Modified Davis grading — 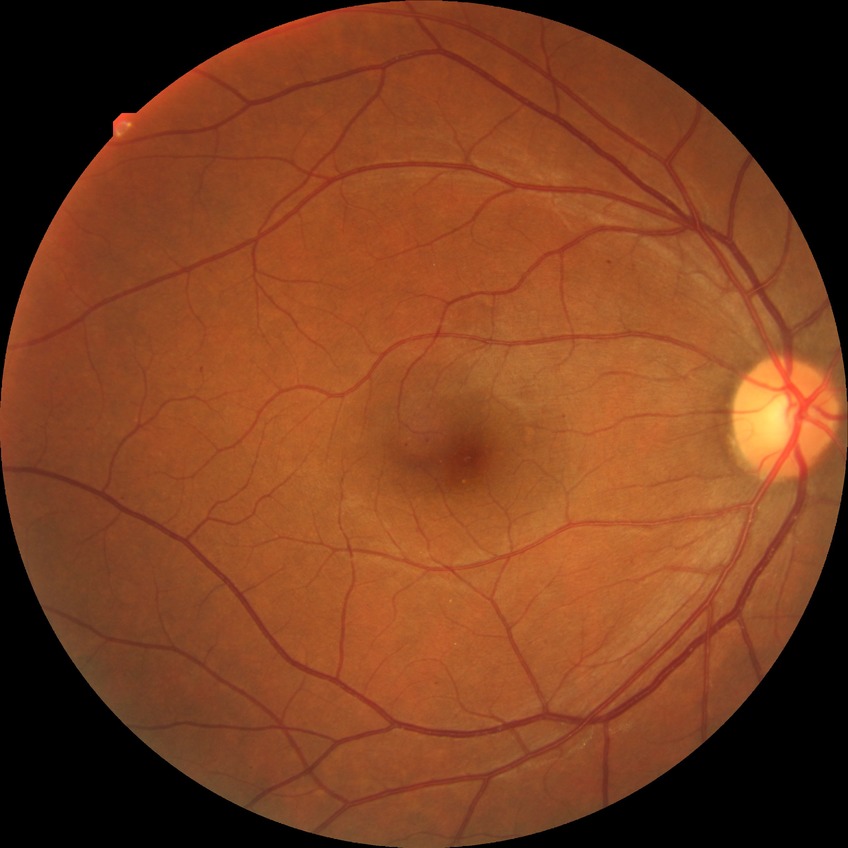 Davis DR grade: SDR.
Disease class: non-proliferative diabetic retinopathy.